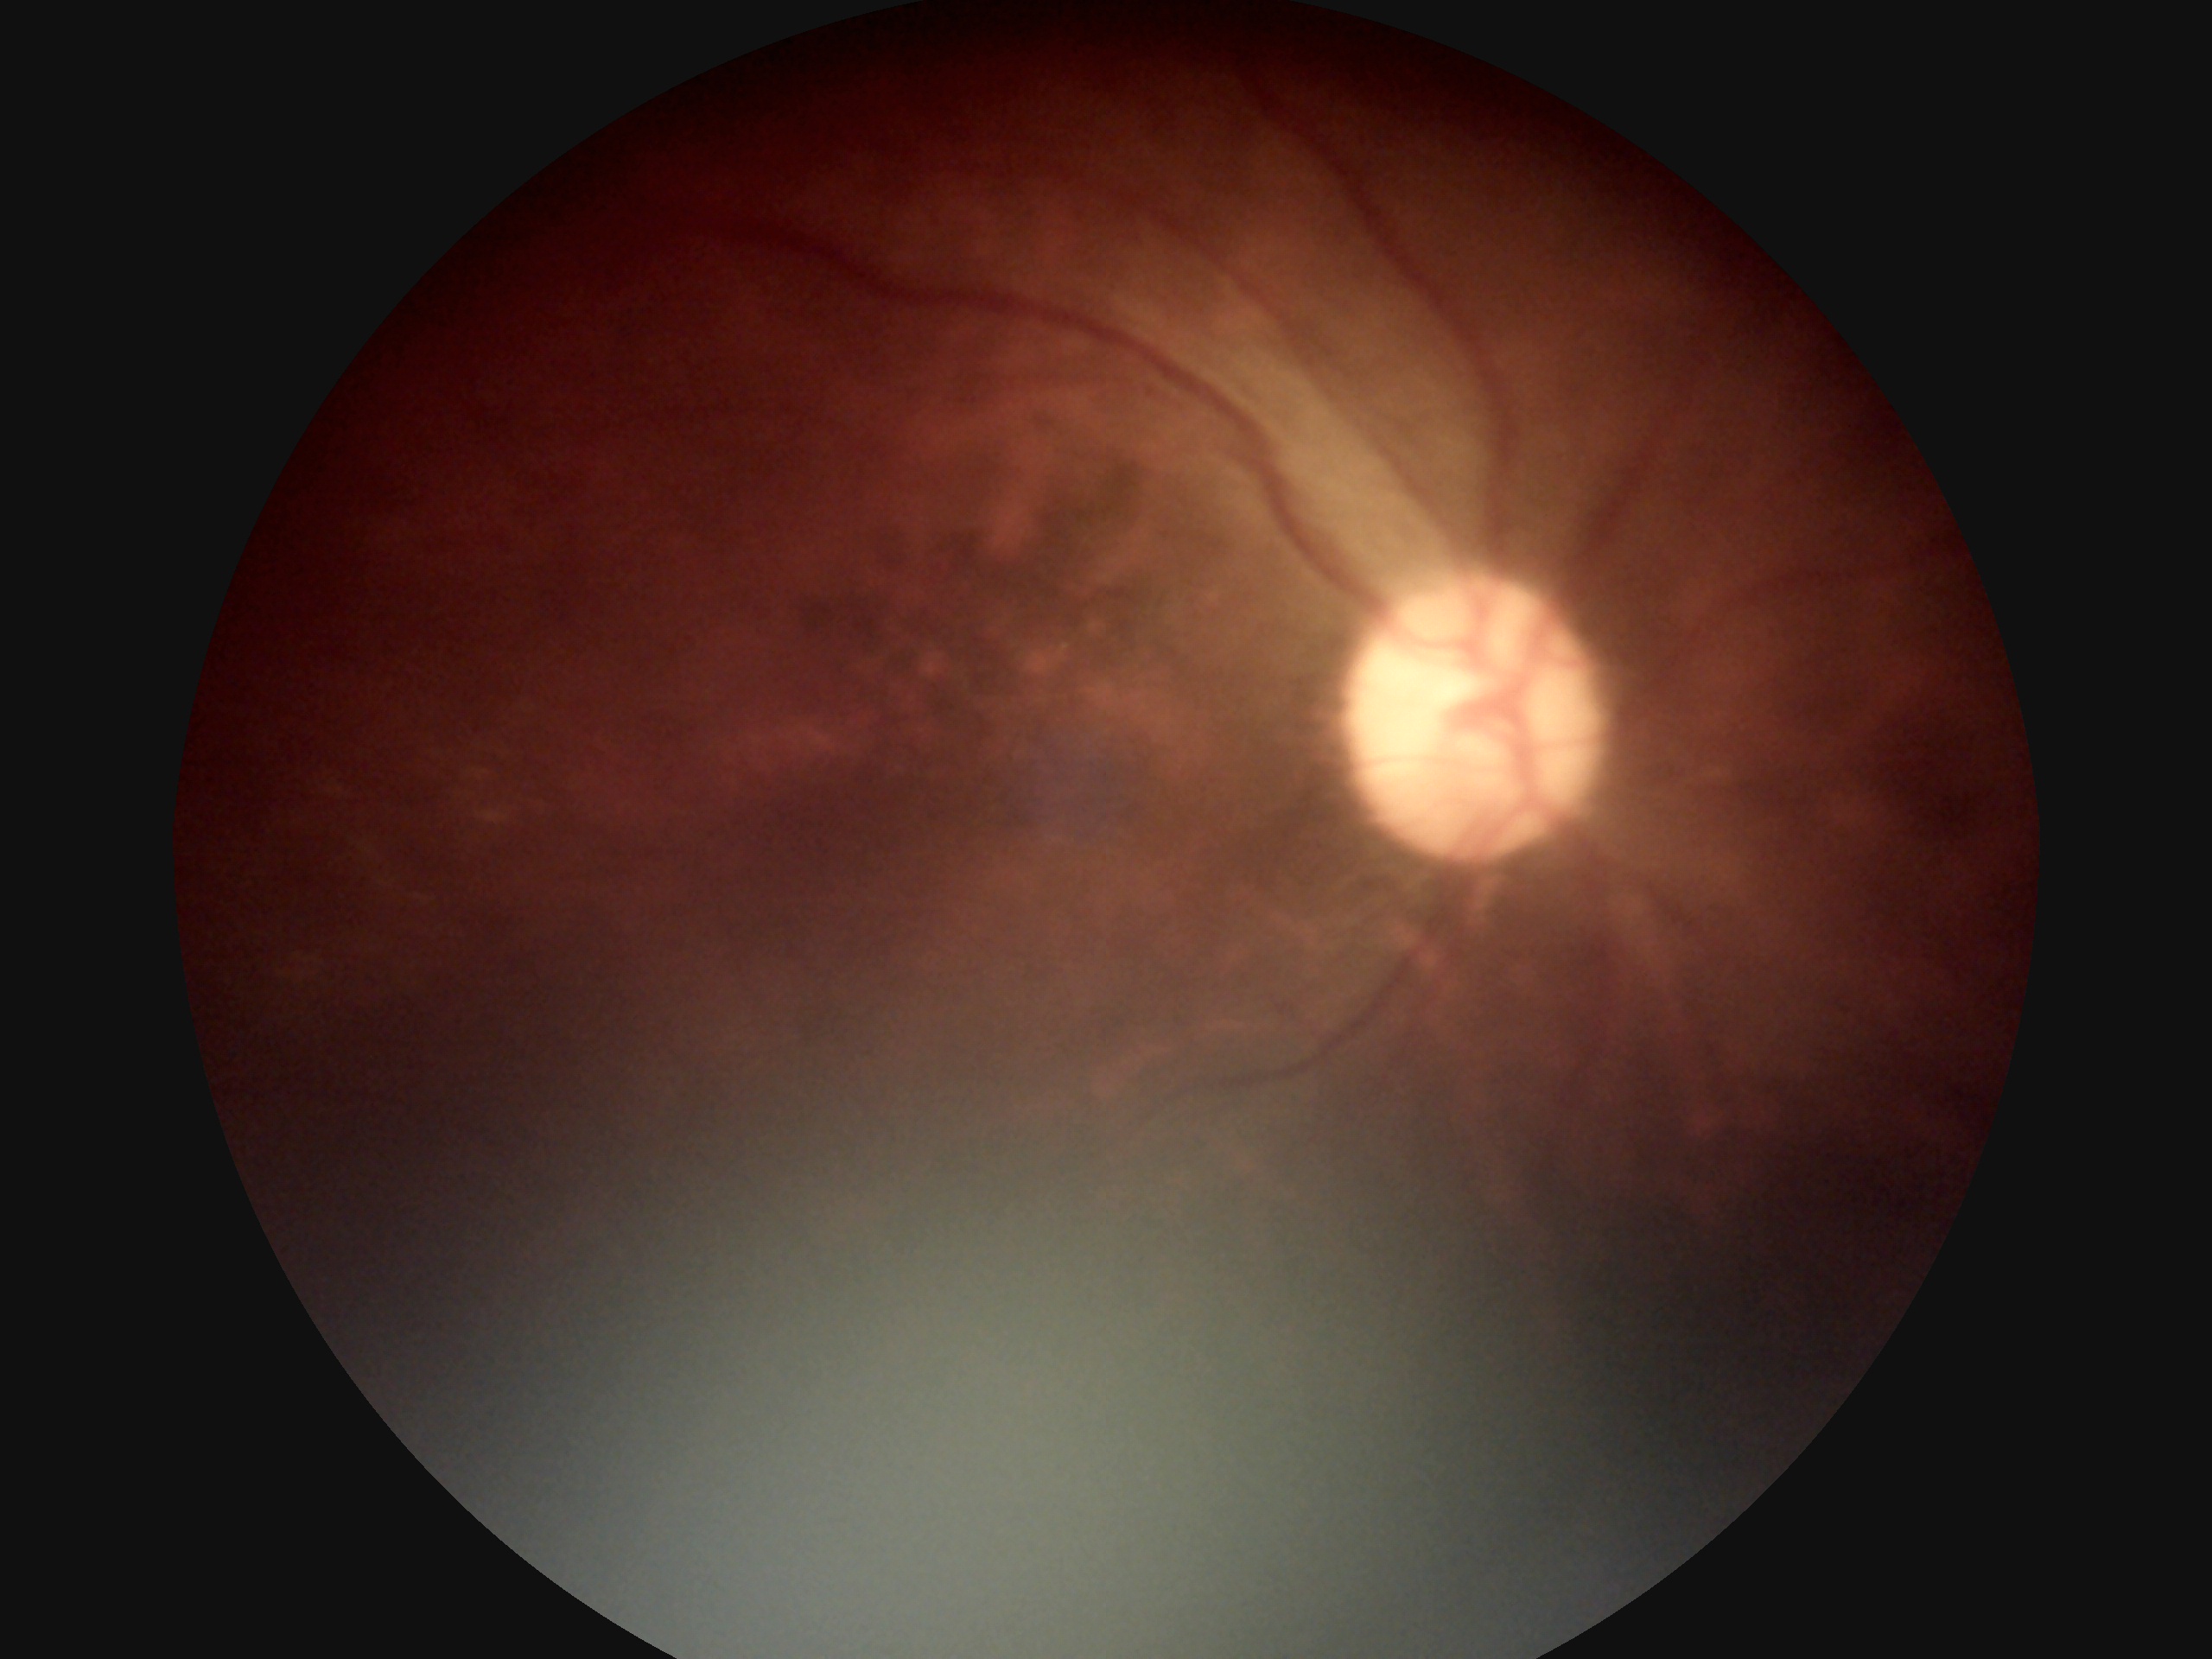 DR stage: 0.